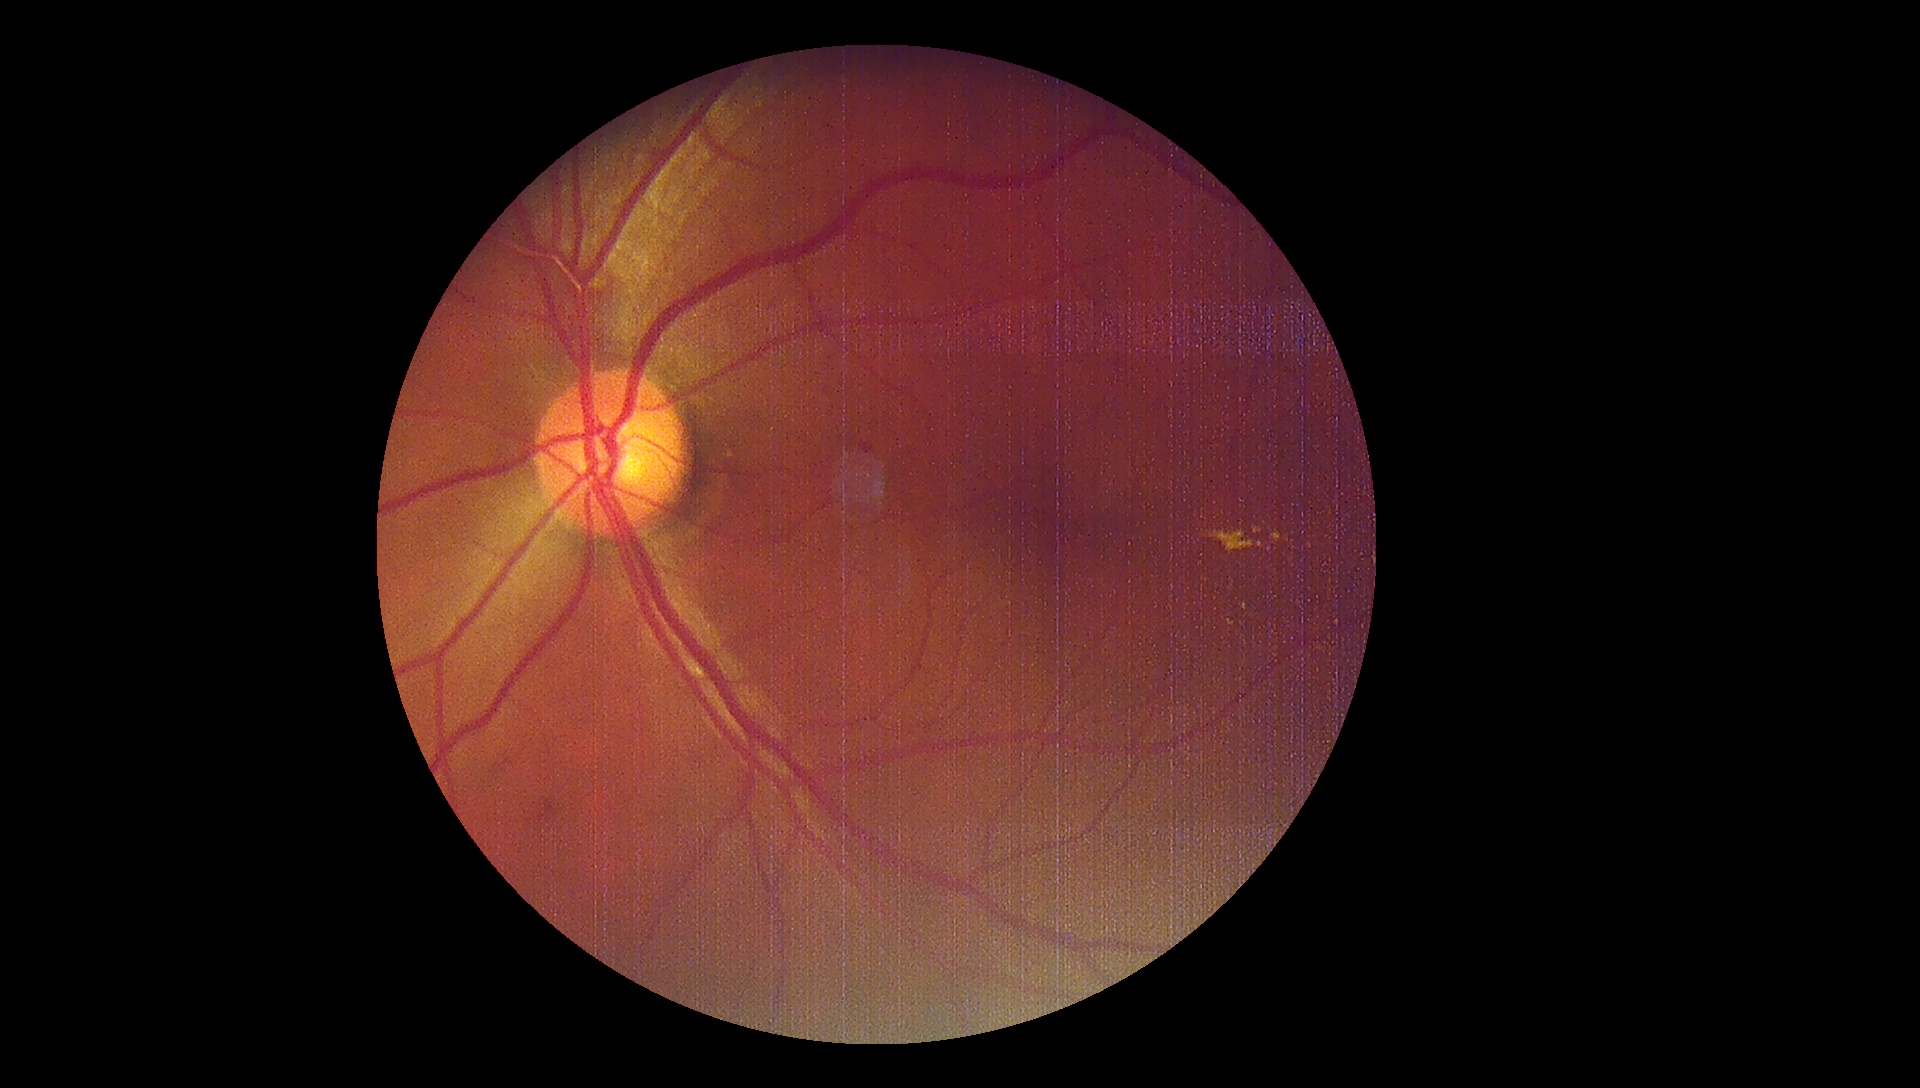
dr_grade: 2/4